Camera: Remidio Fundus on Phone (FOP) camera — 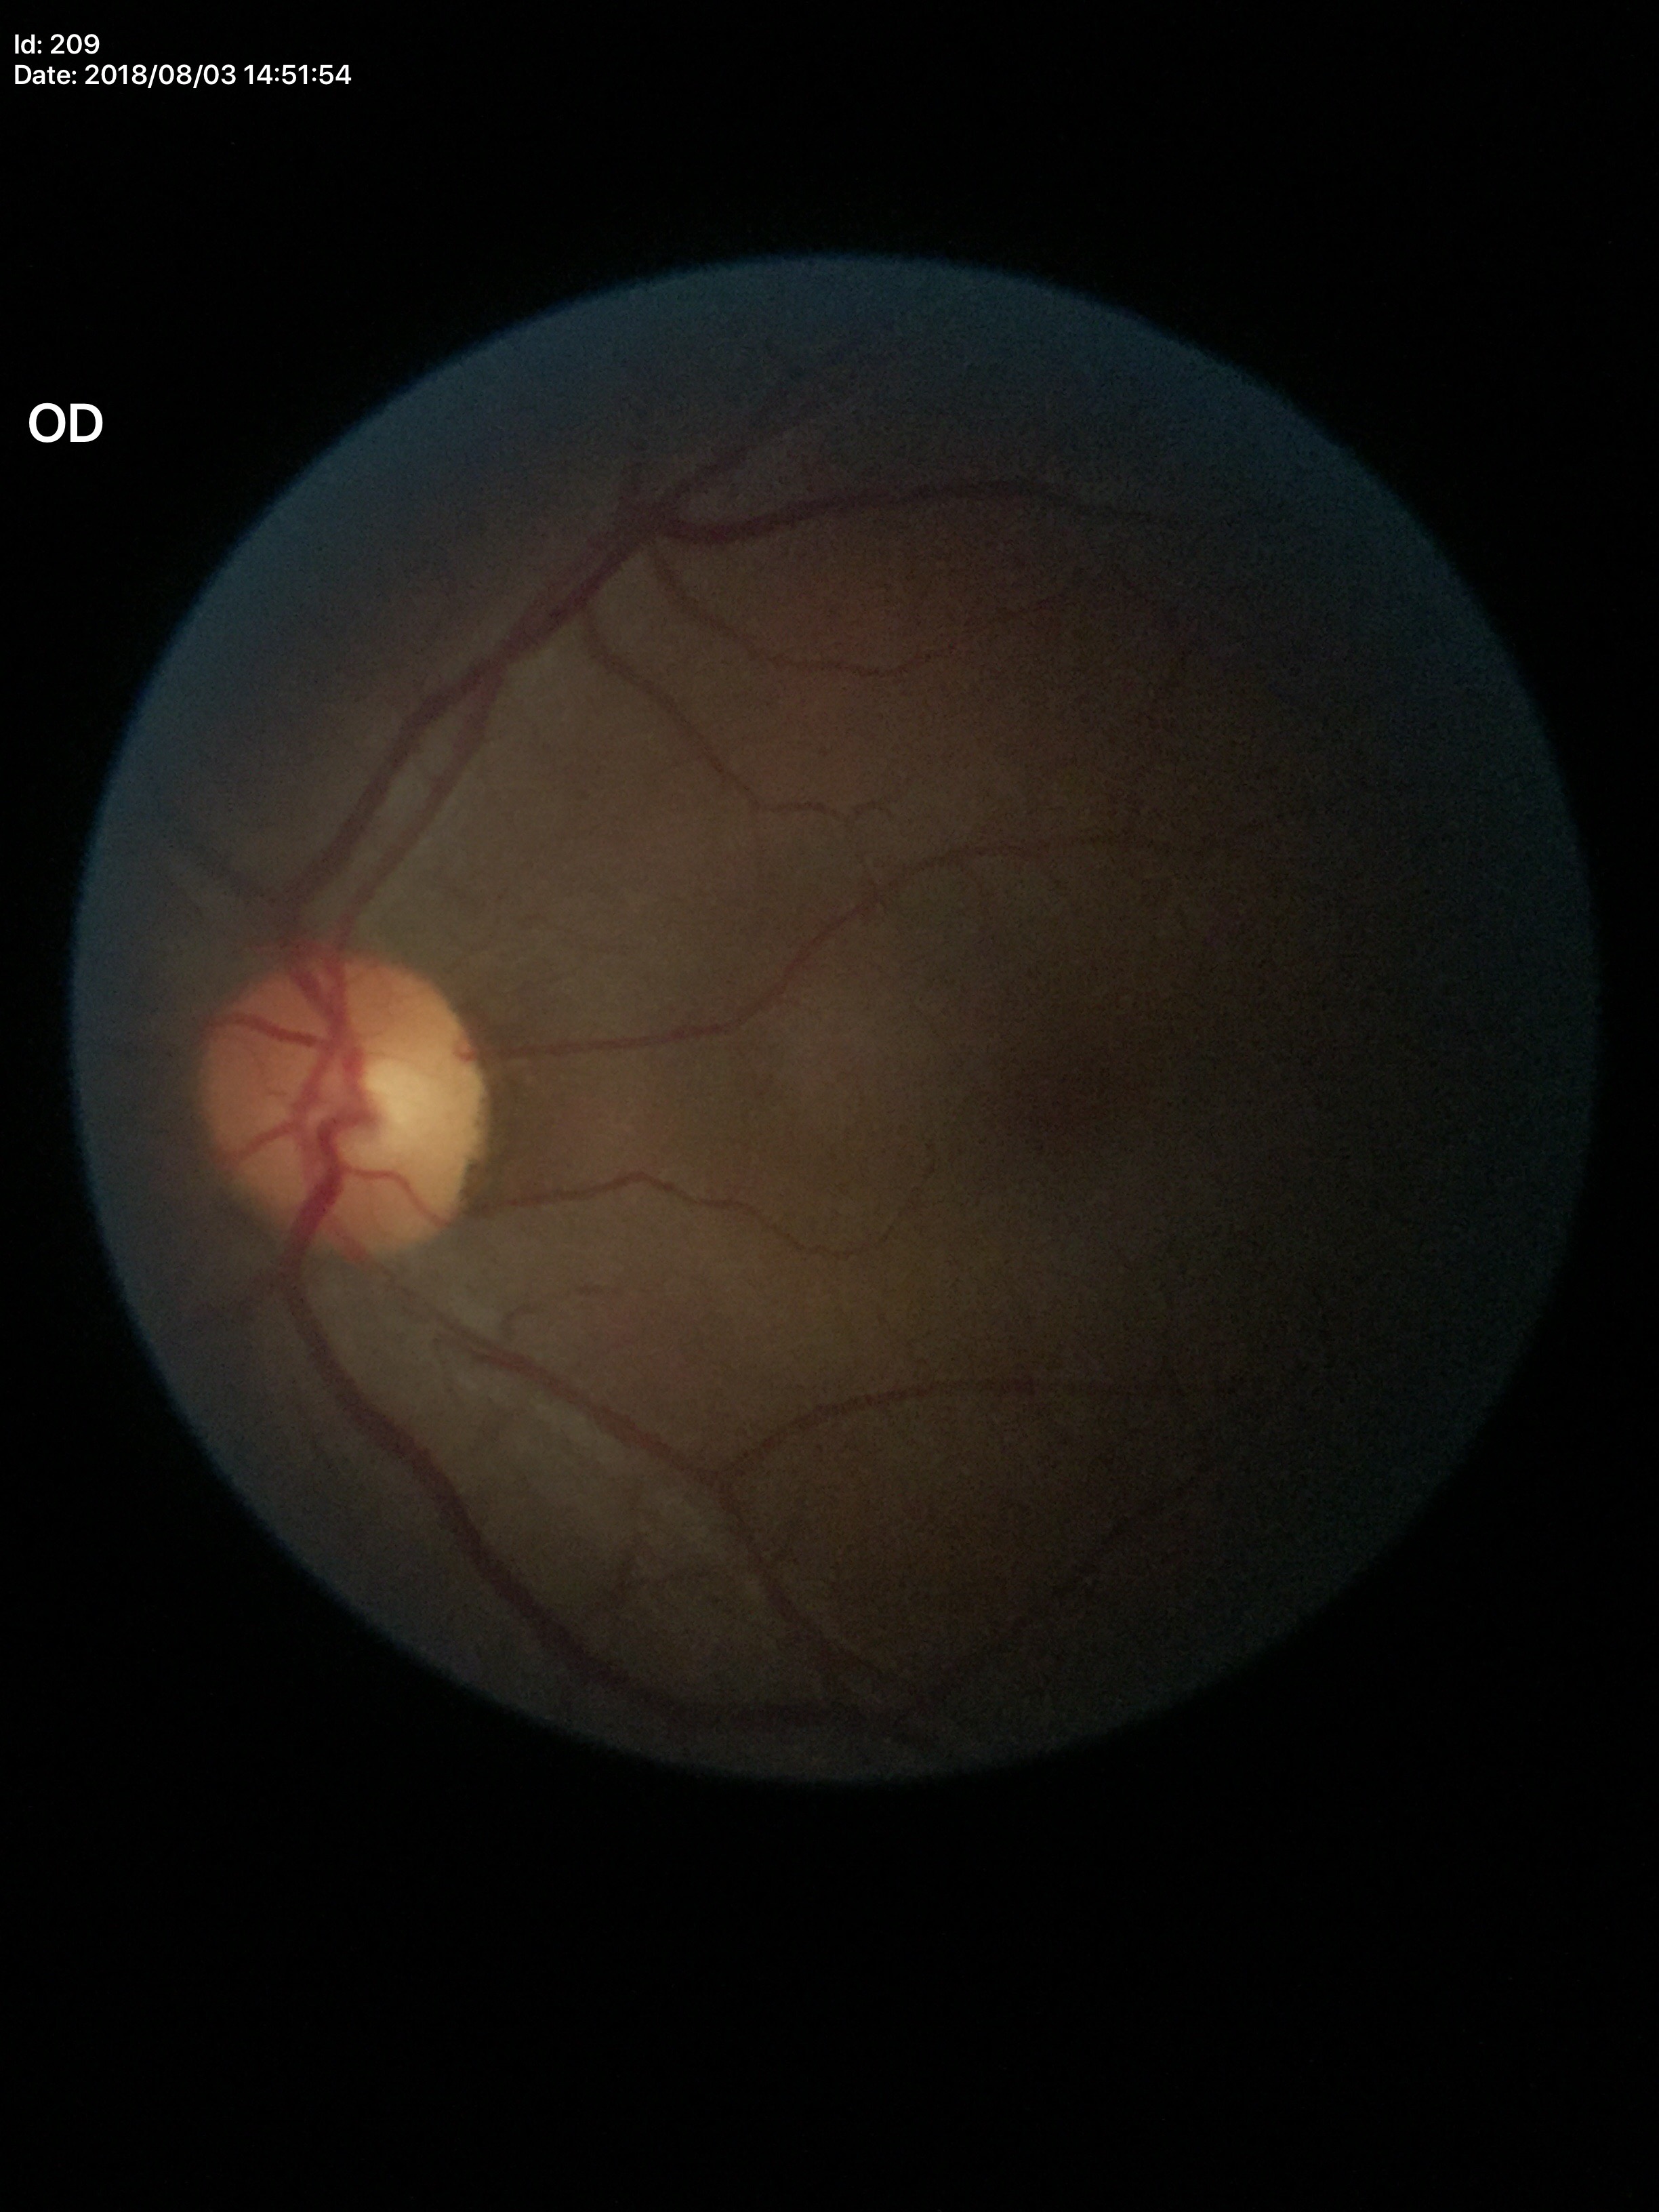

Vertical cup-to-disc ratio (VCDR) is 0.47.
Horizontal cup-disc ratio (HCDR): 0.49.
No glaucomatous optic neuropathy (5/5 ophthalmologists in agreement).